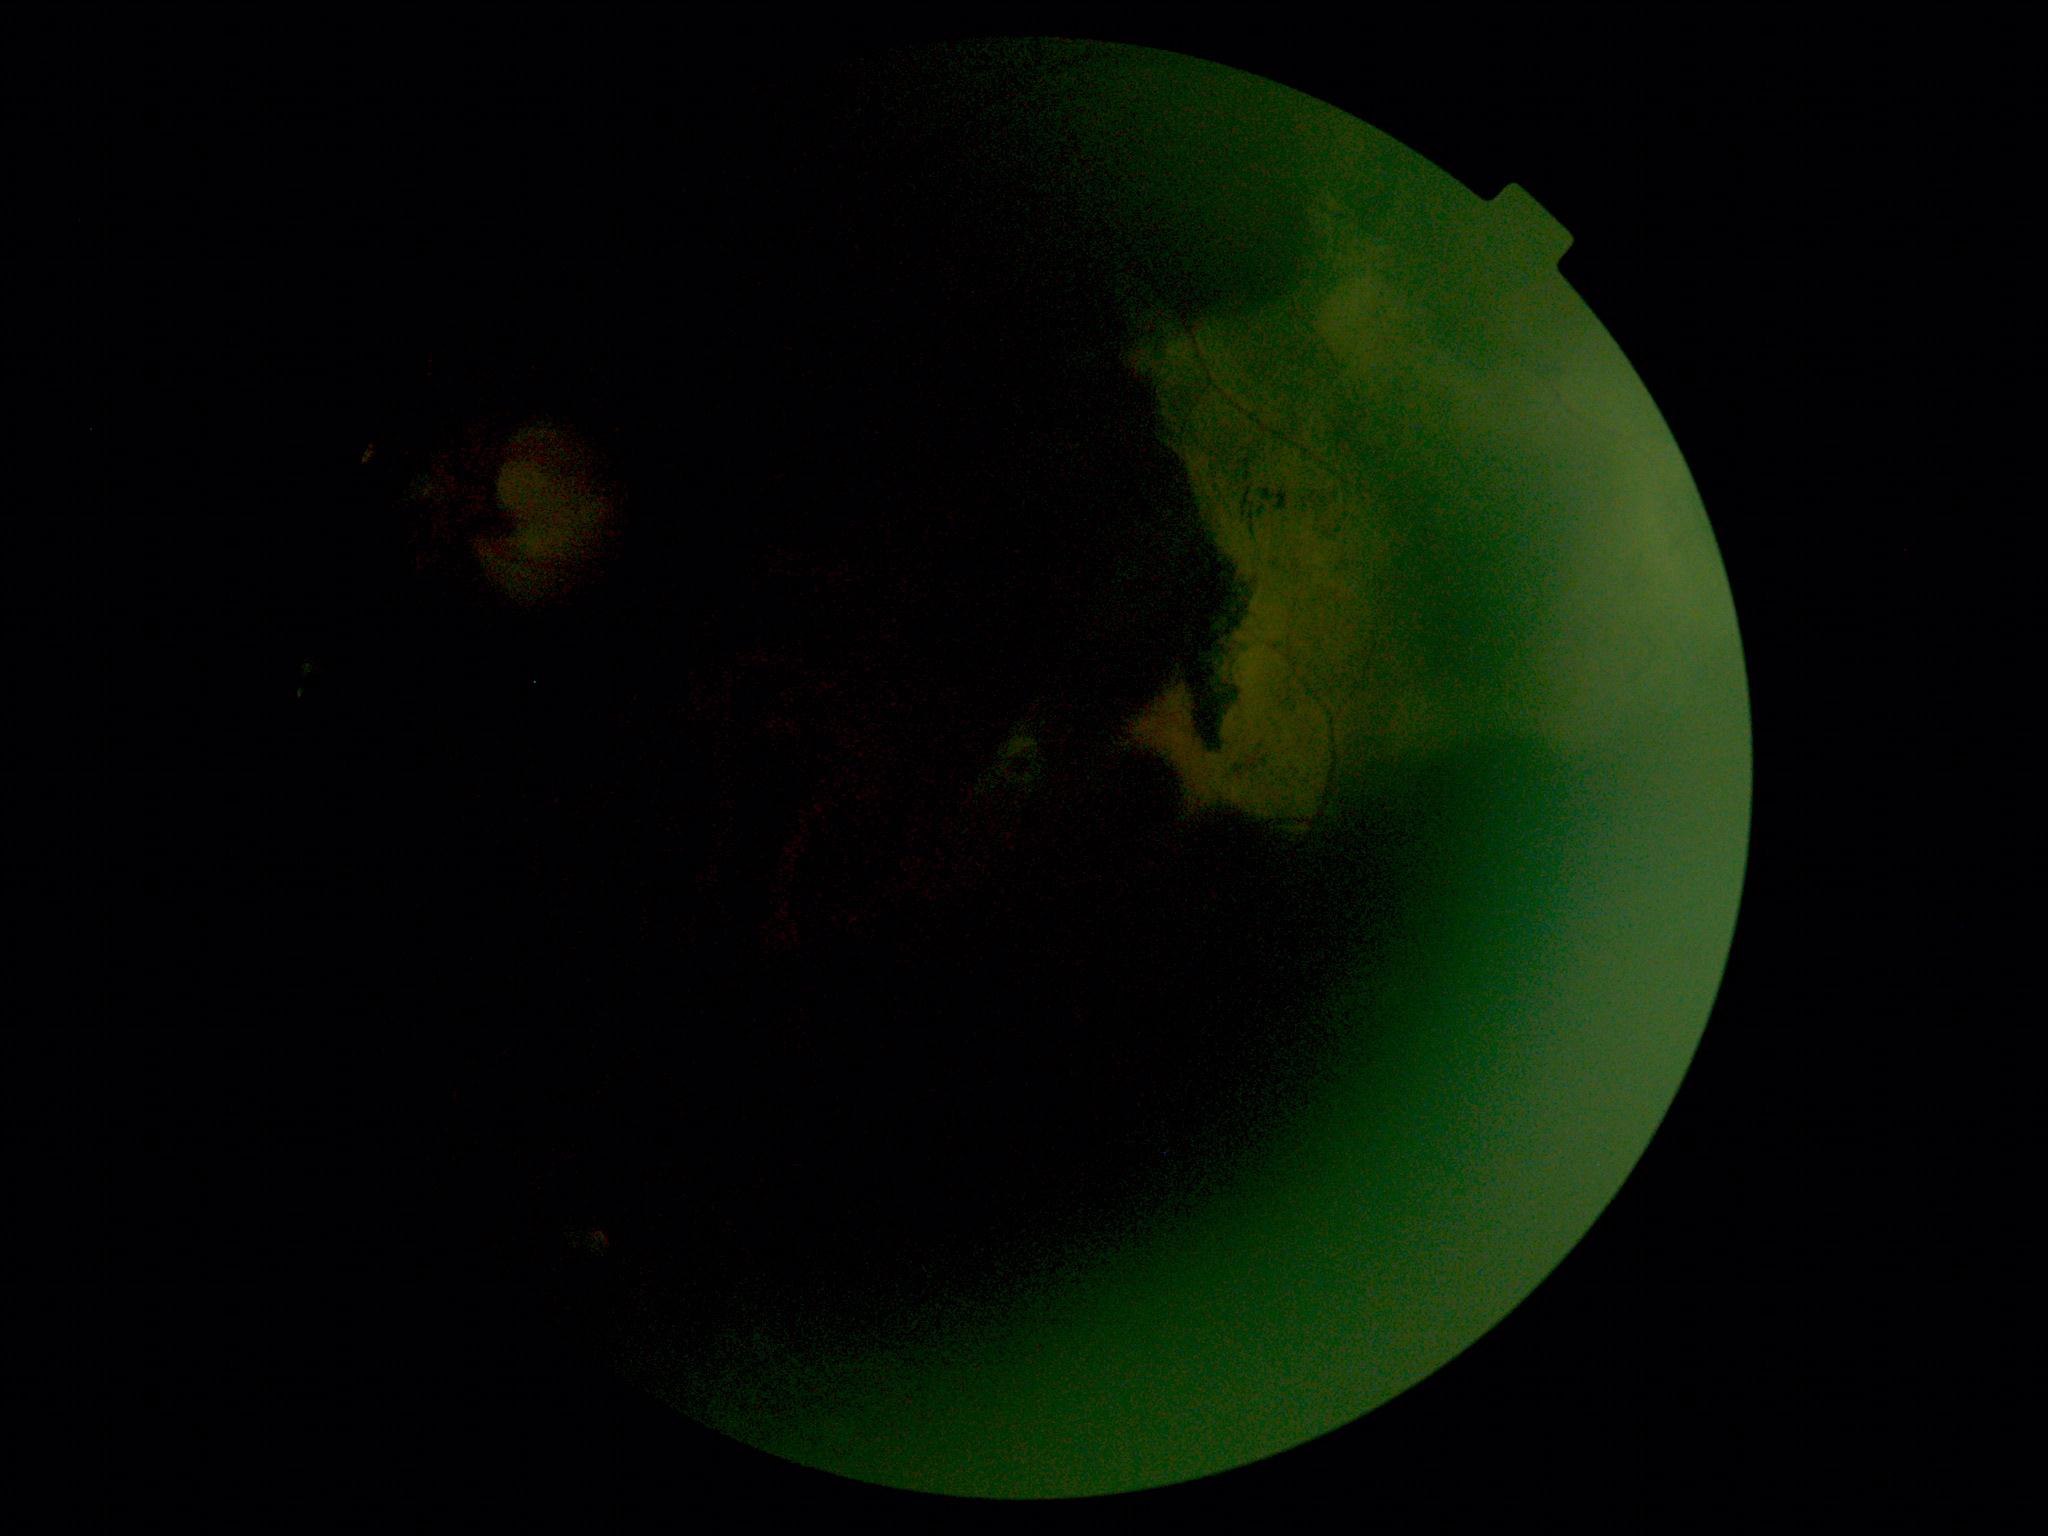

  dr_grade: ungradable
  quality: too poor for DR grading